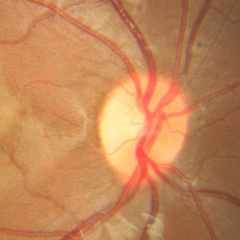 Assessment: no glaucoma.